412 by 310 pixels. Color fundus image: 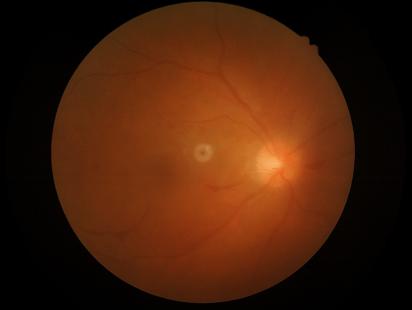

Noticeable blur in the optic disc, vessels, or background.
Overall quality is poor; the image is difficult to grade.
Contrast is good.
Illumination is uneven.